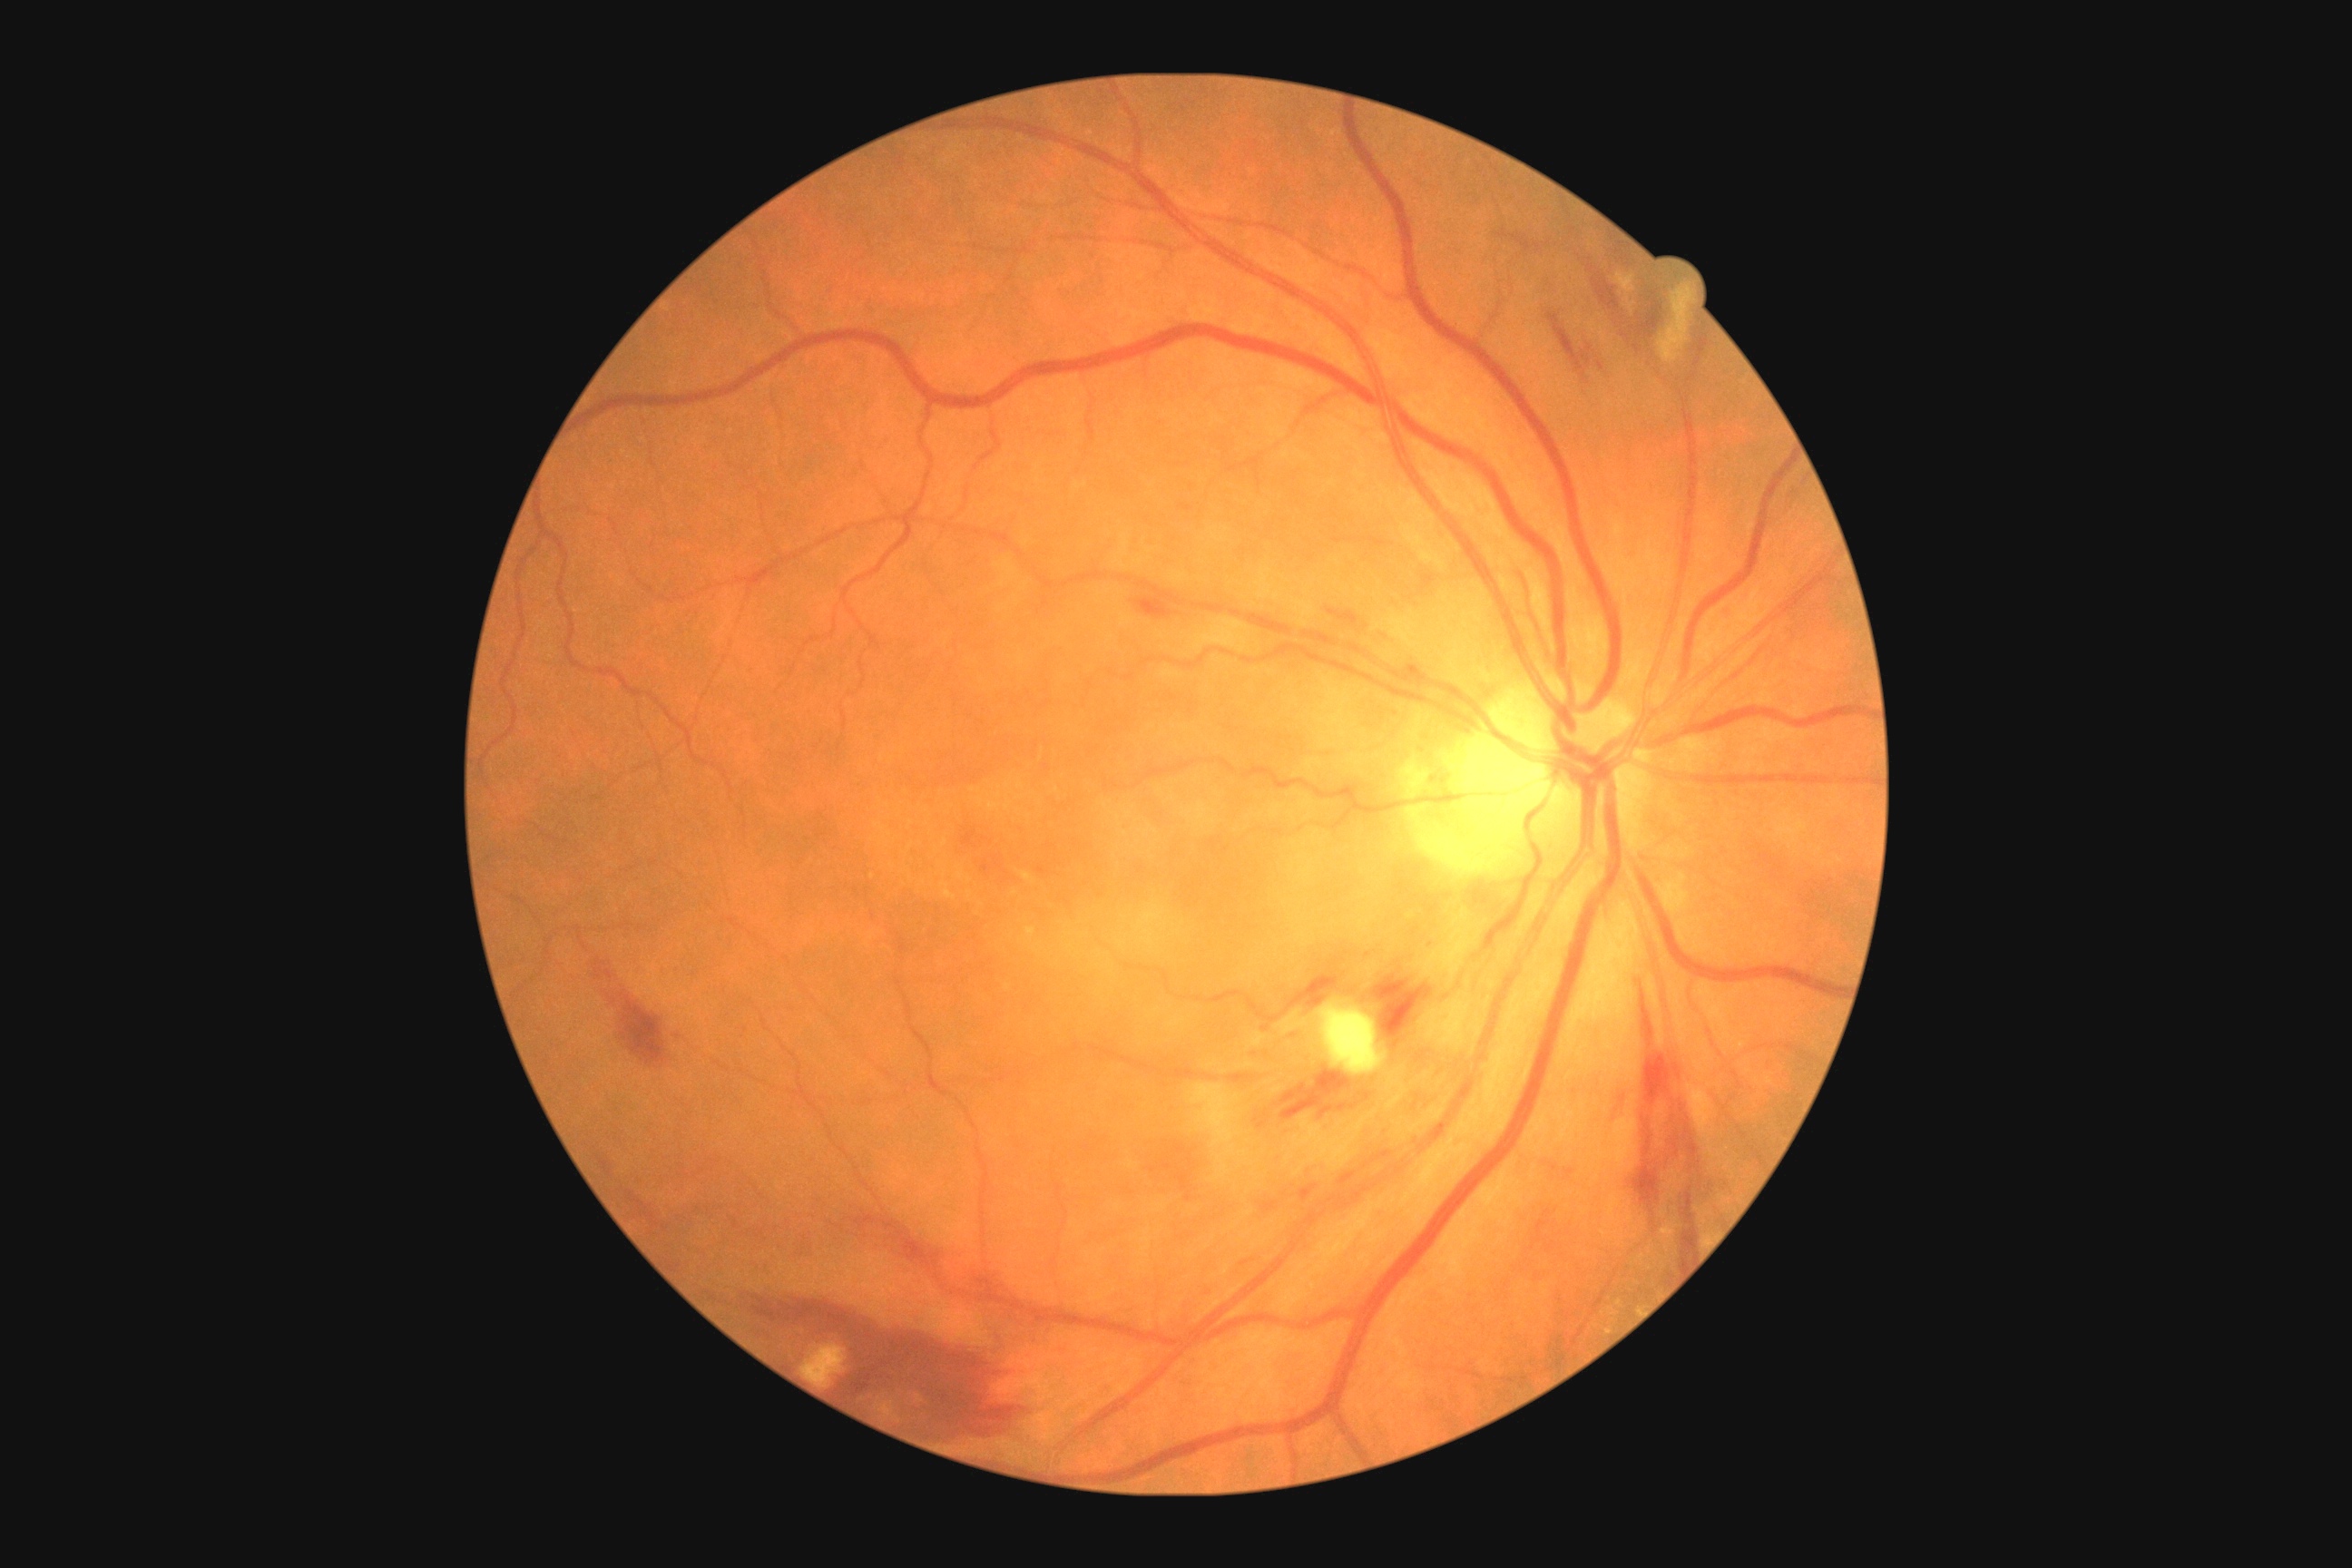
Annotations:
- diabetic retinopathy (DR) — grade 2